2352 by 1568 pixels, 45-degree field of view:
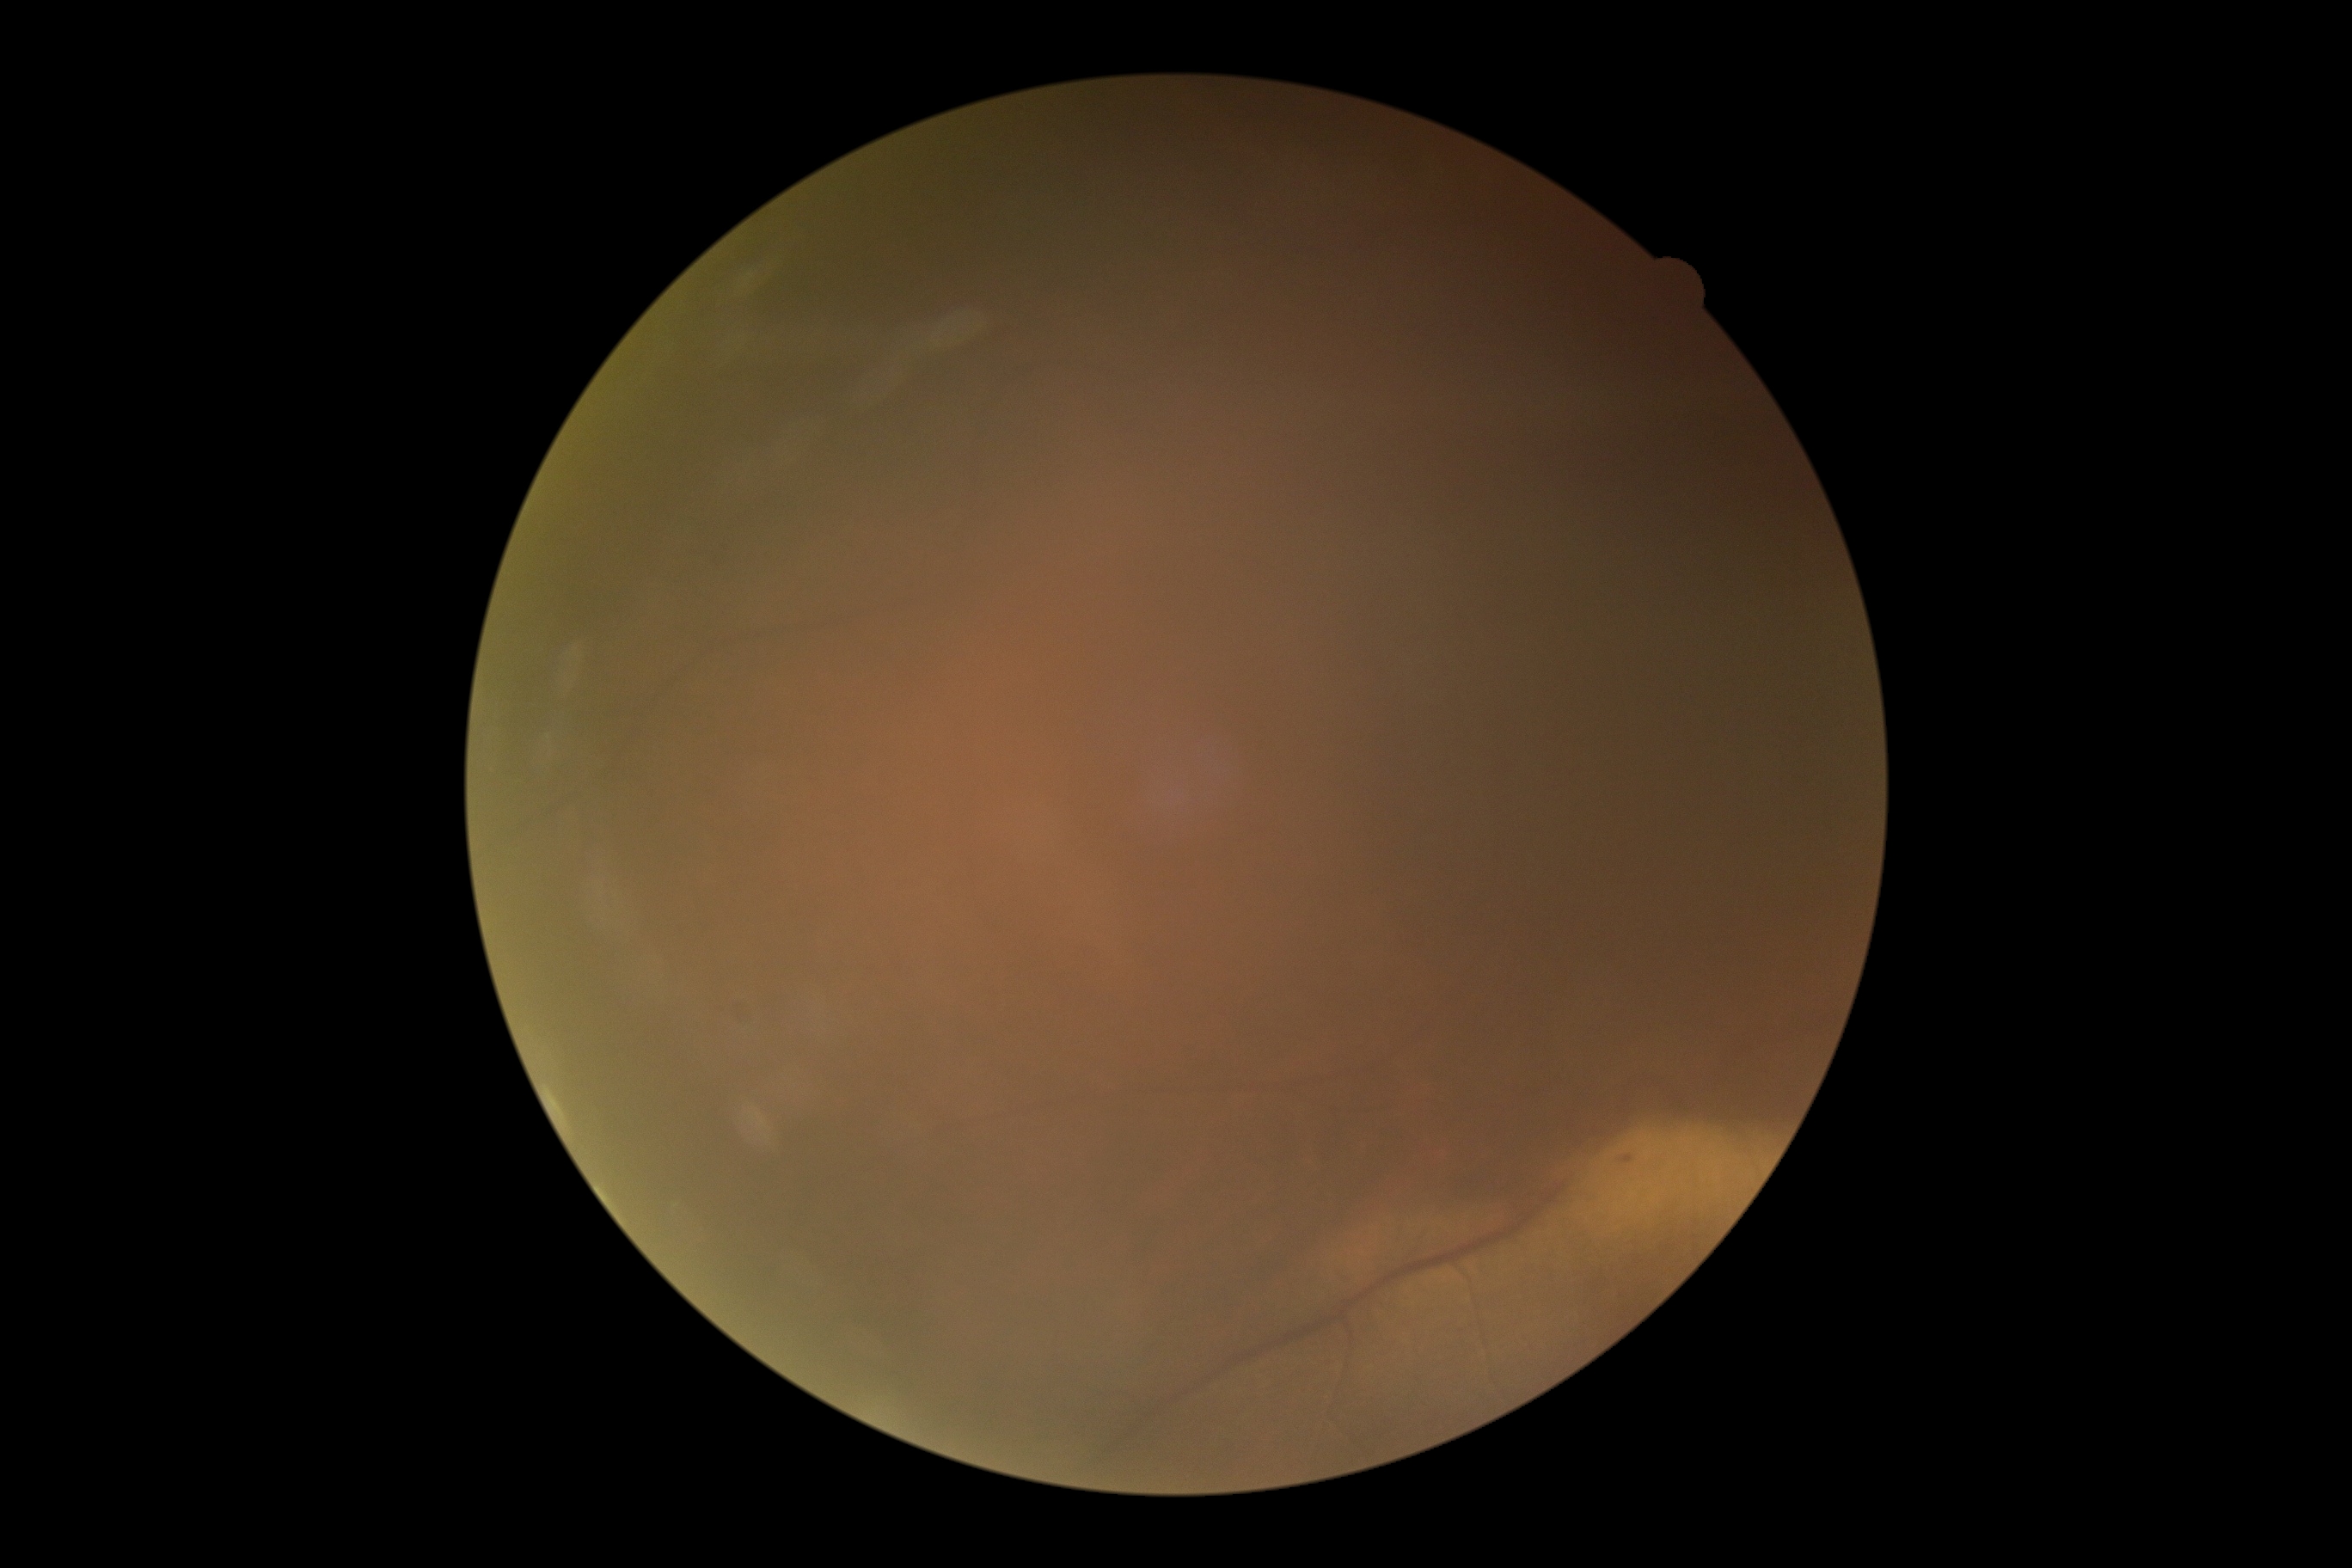 Diabetic retinopathy is ungradable due to poor image quality.